Color fundus image; 848 by 848 pixels; nonmydriatic: 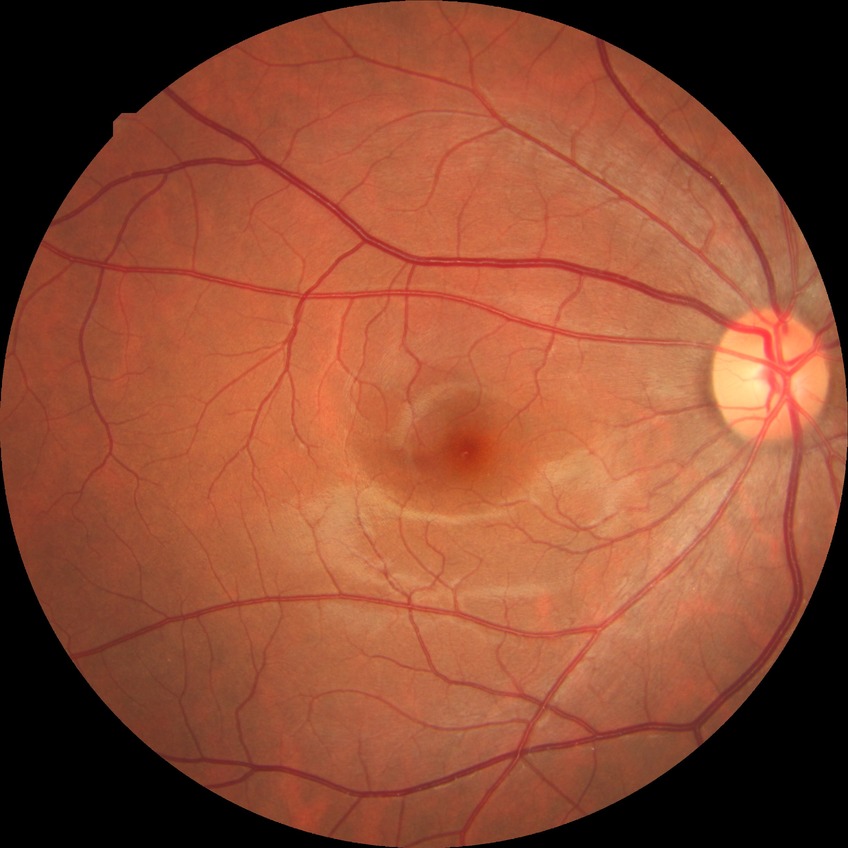 Modified Davis grading is no diabetic retinopathy.